Mydriatic. Acquired with a Topcon TRC. Fundus image cropped to the optic disc
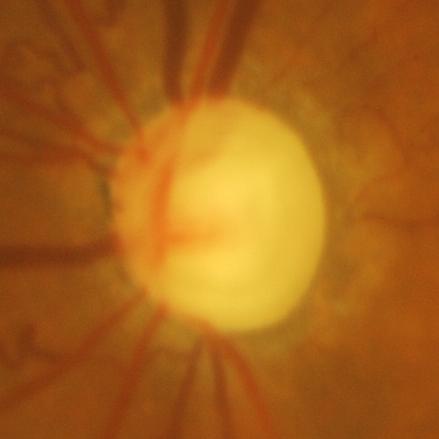 Glaucomatous optic neuropathy.